NIDEK AFC-230 fundus camera: 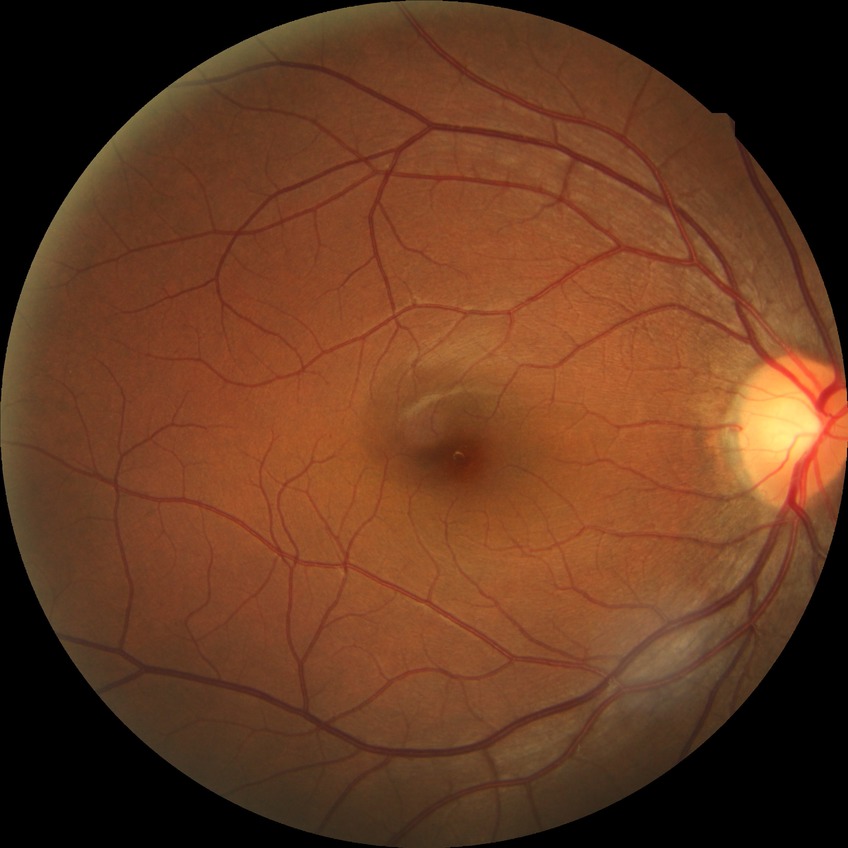

diabetic retinopathy (DR) = NDR (no diabetic retinopathy).